1440 by 1080 pixels · infant wide-field fundus photograph
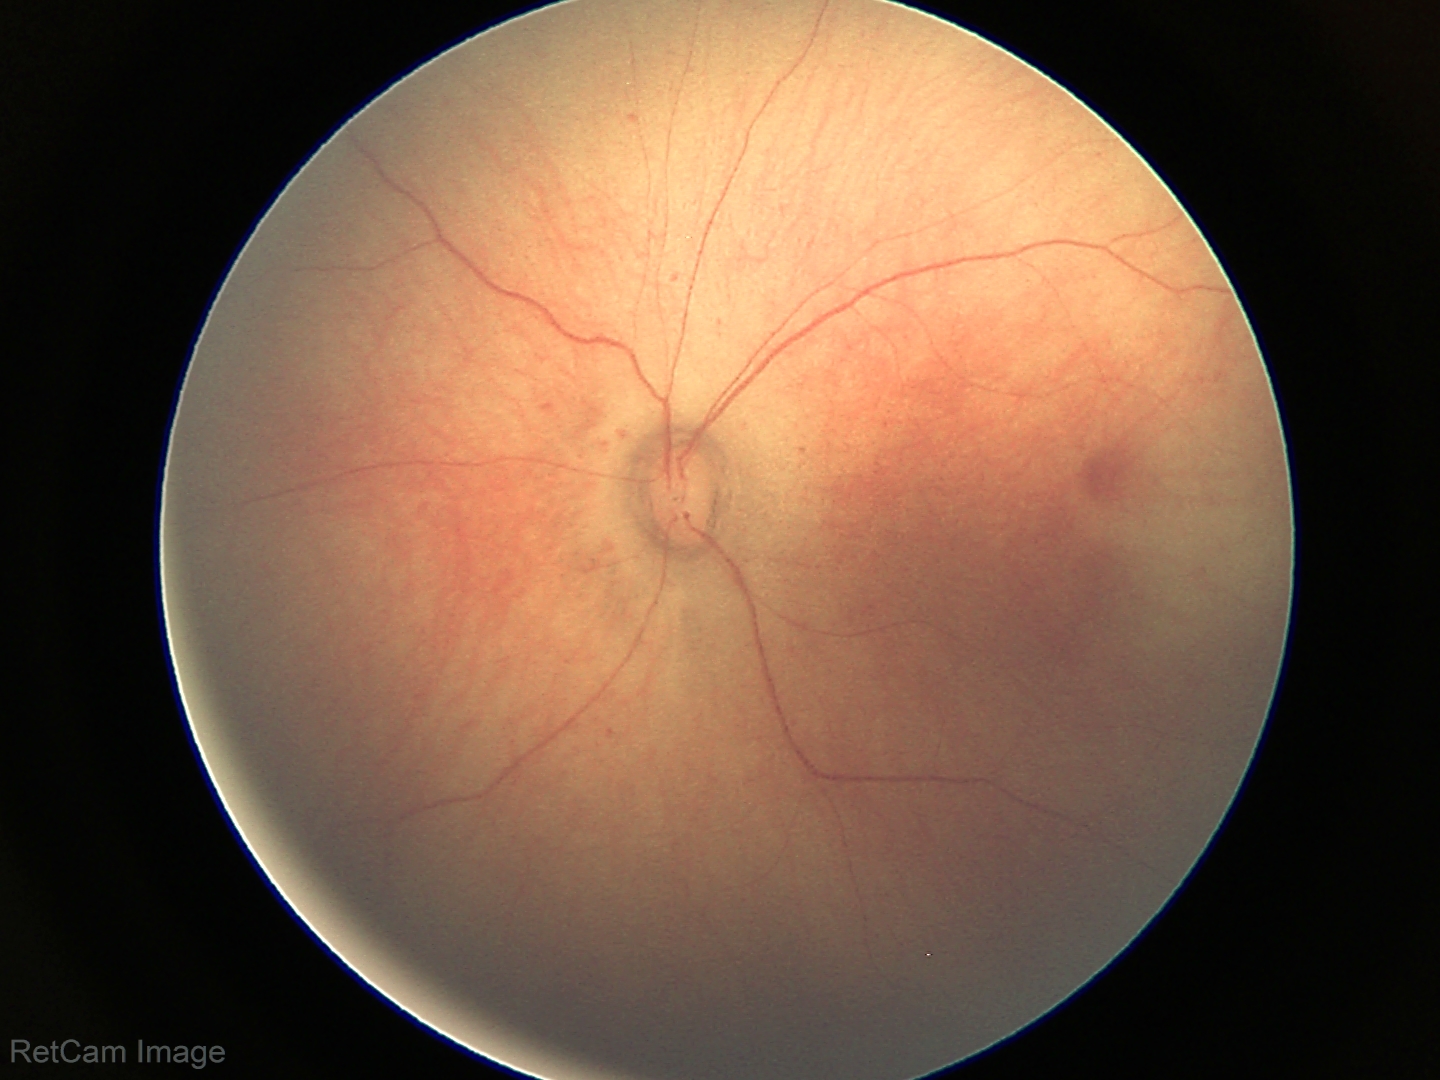

No retinal pathology identified on screening.